No pharmacologic dilation
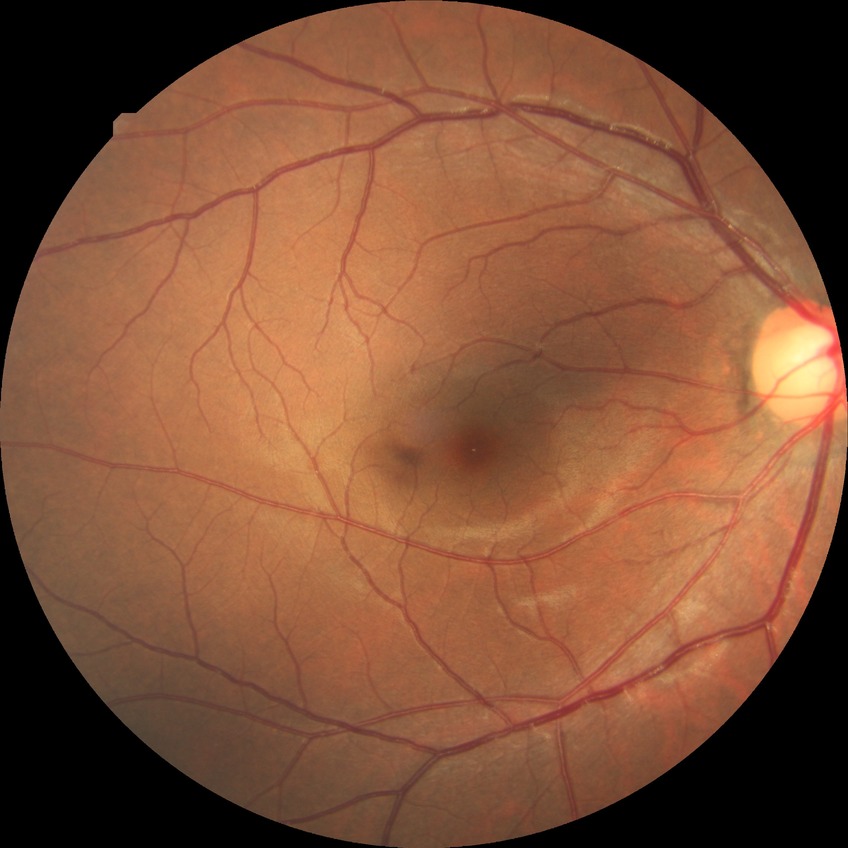
davis_grade: no diabetic retinopathy